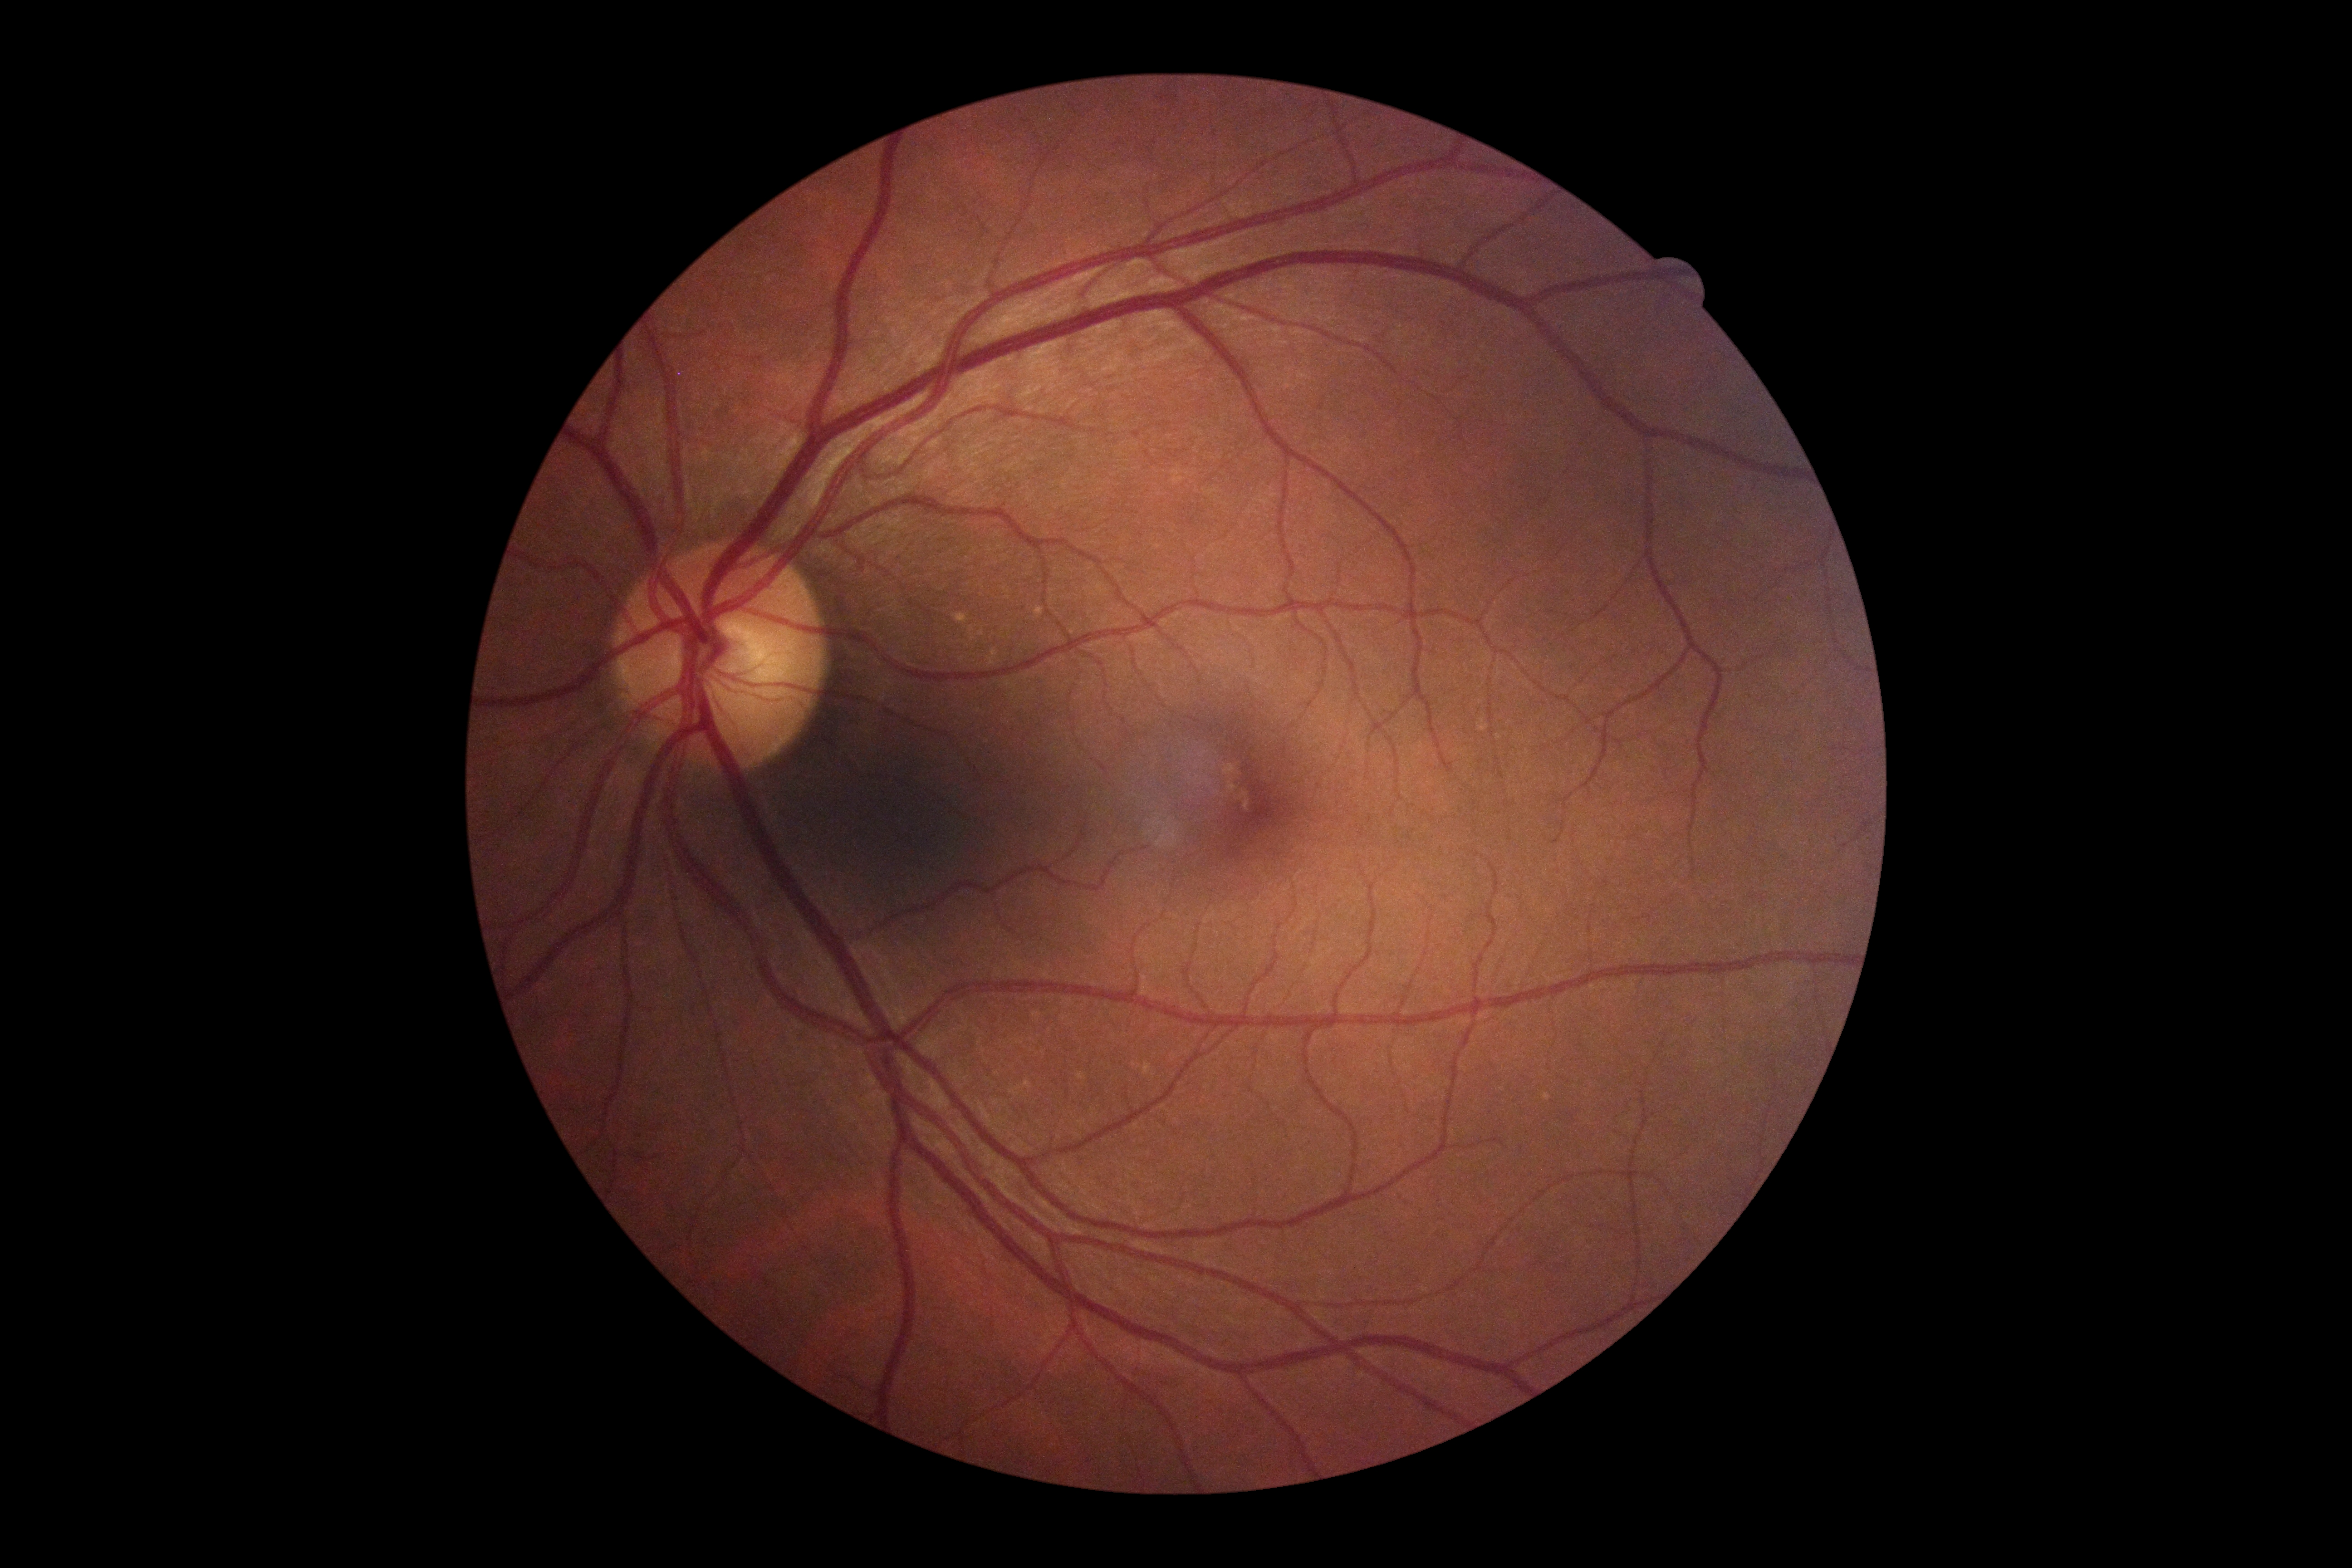
DR grade is no apparent retinopathy (0).